Modified Davis grading; no pharmacologic dilation; image size 848x848 — 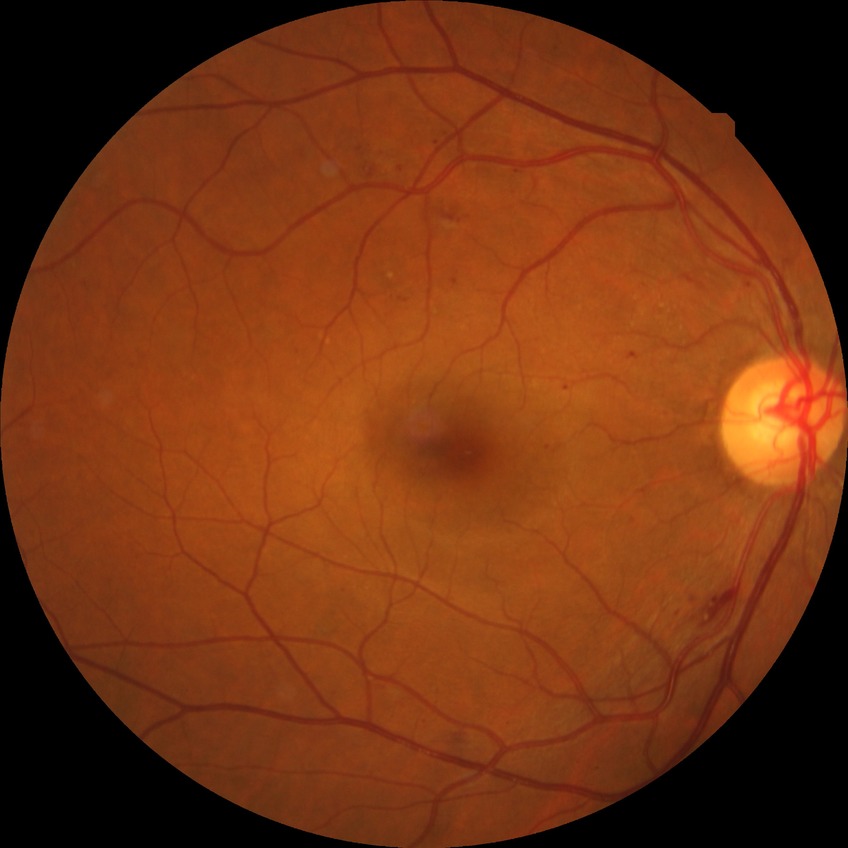 Davis grading: simple diabetic retinopathy.